No pharmacologic dilation
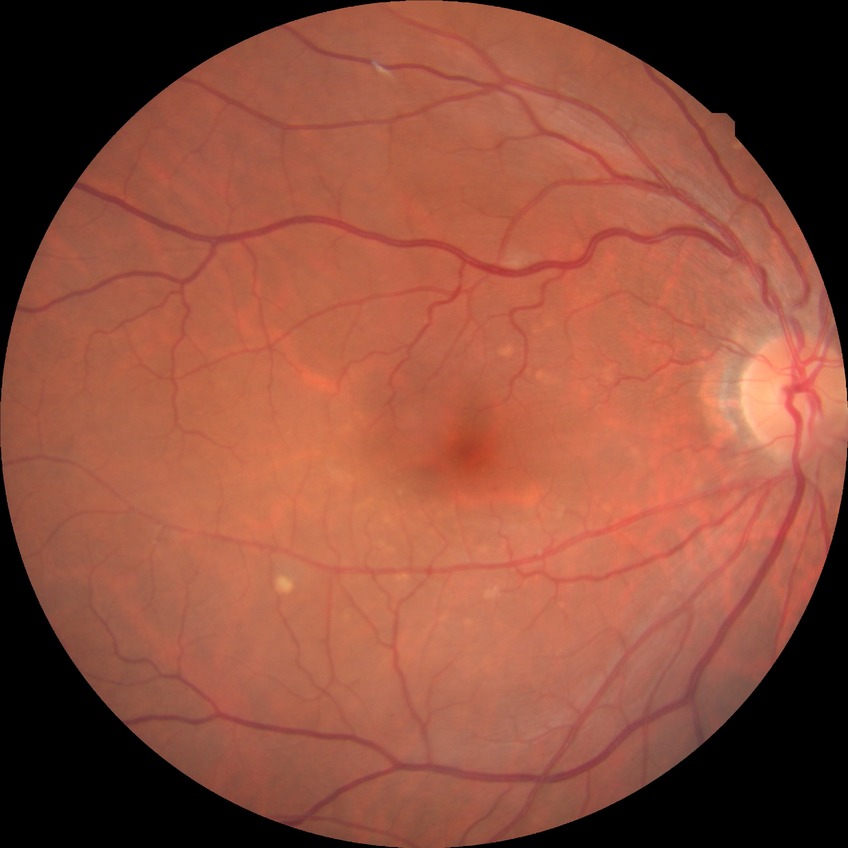

Retinopathy stage is no diabetic retinopathy.